2352x1568px. Color fundus image.
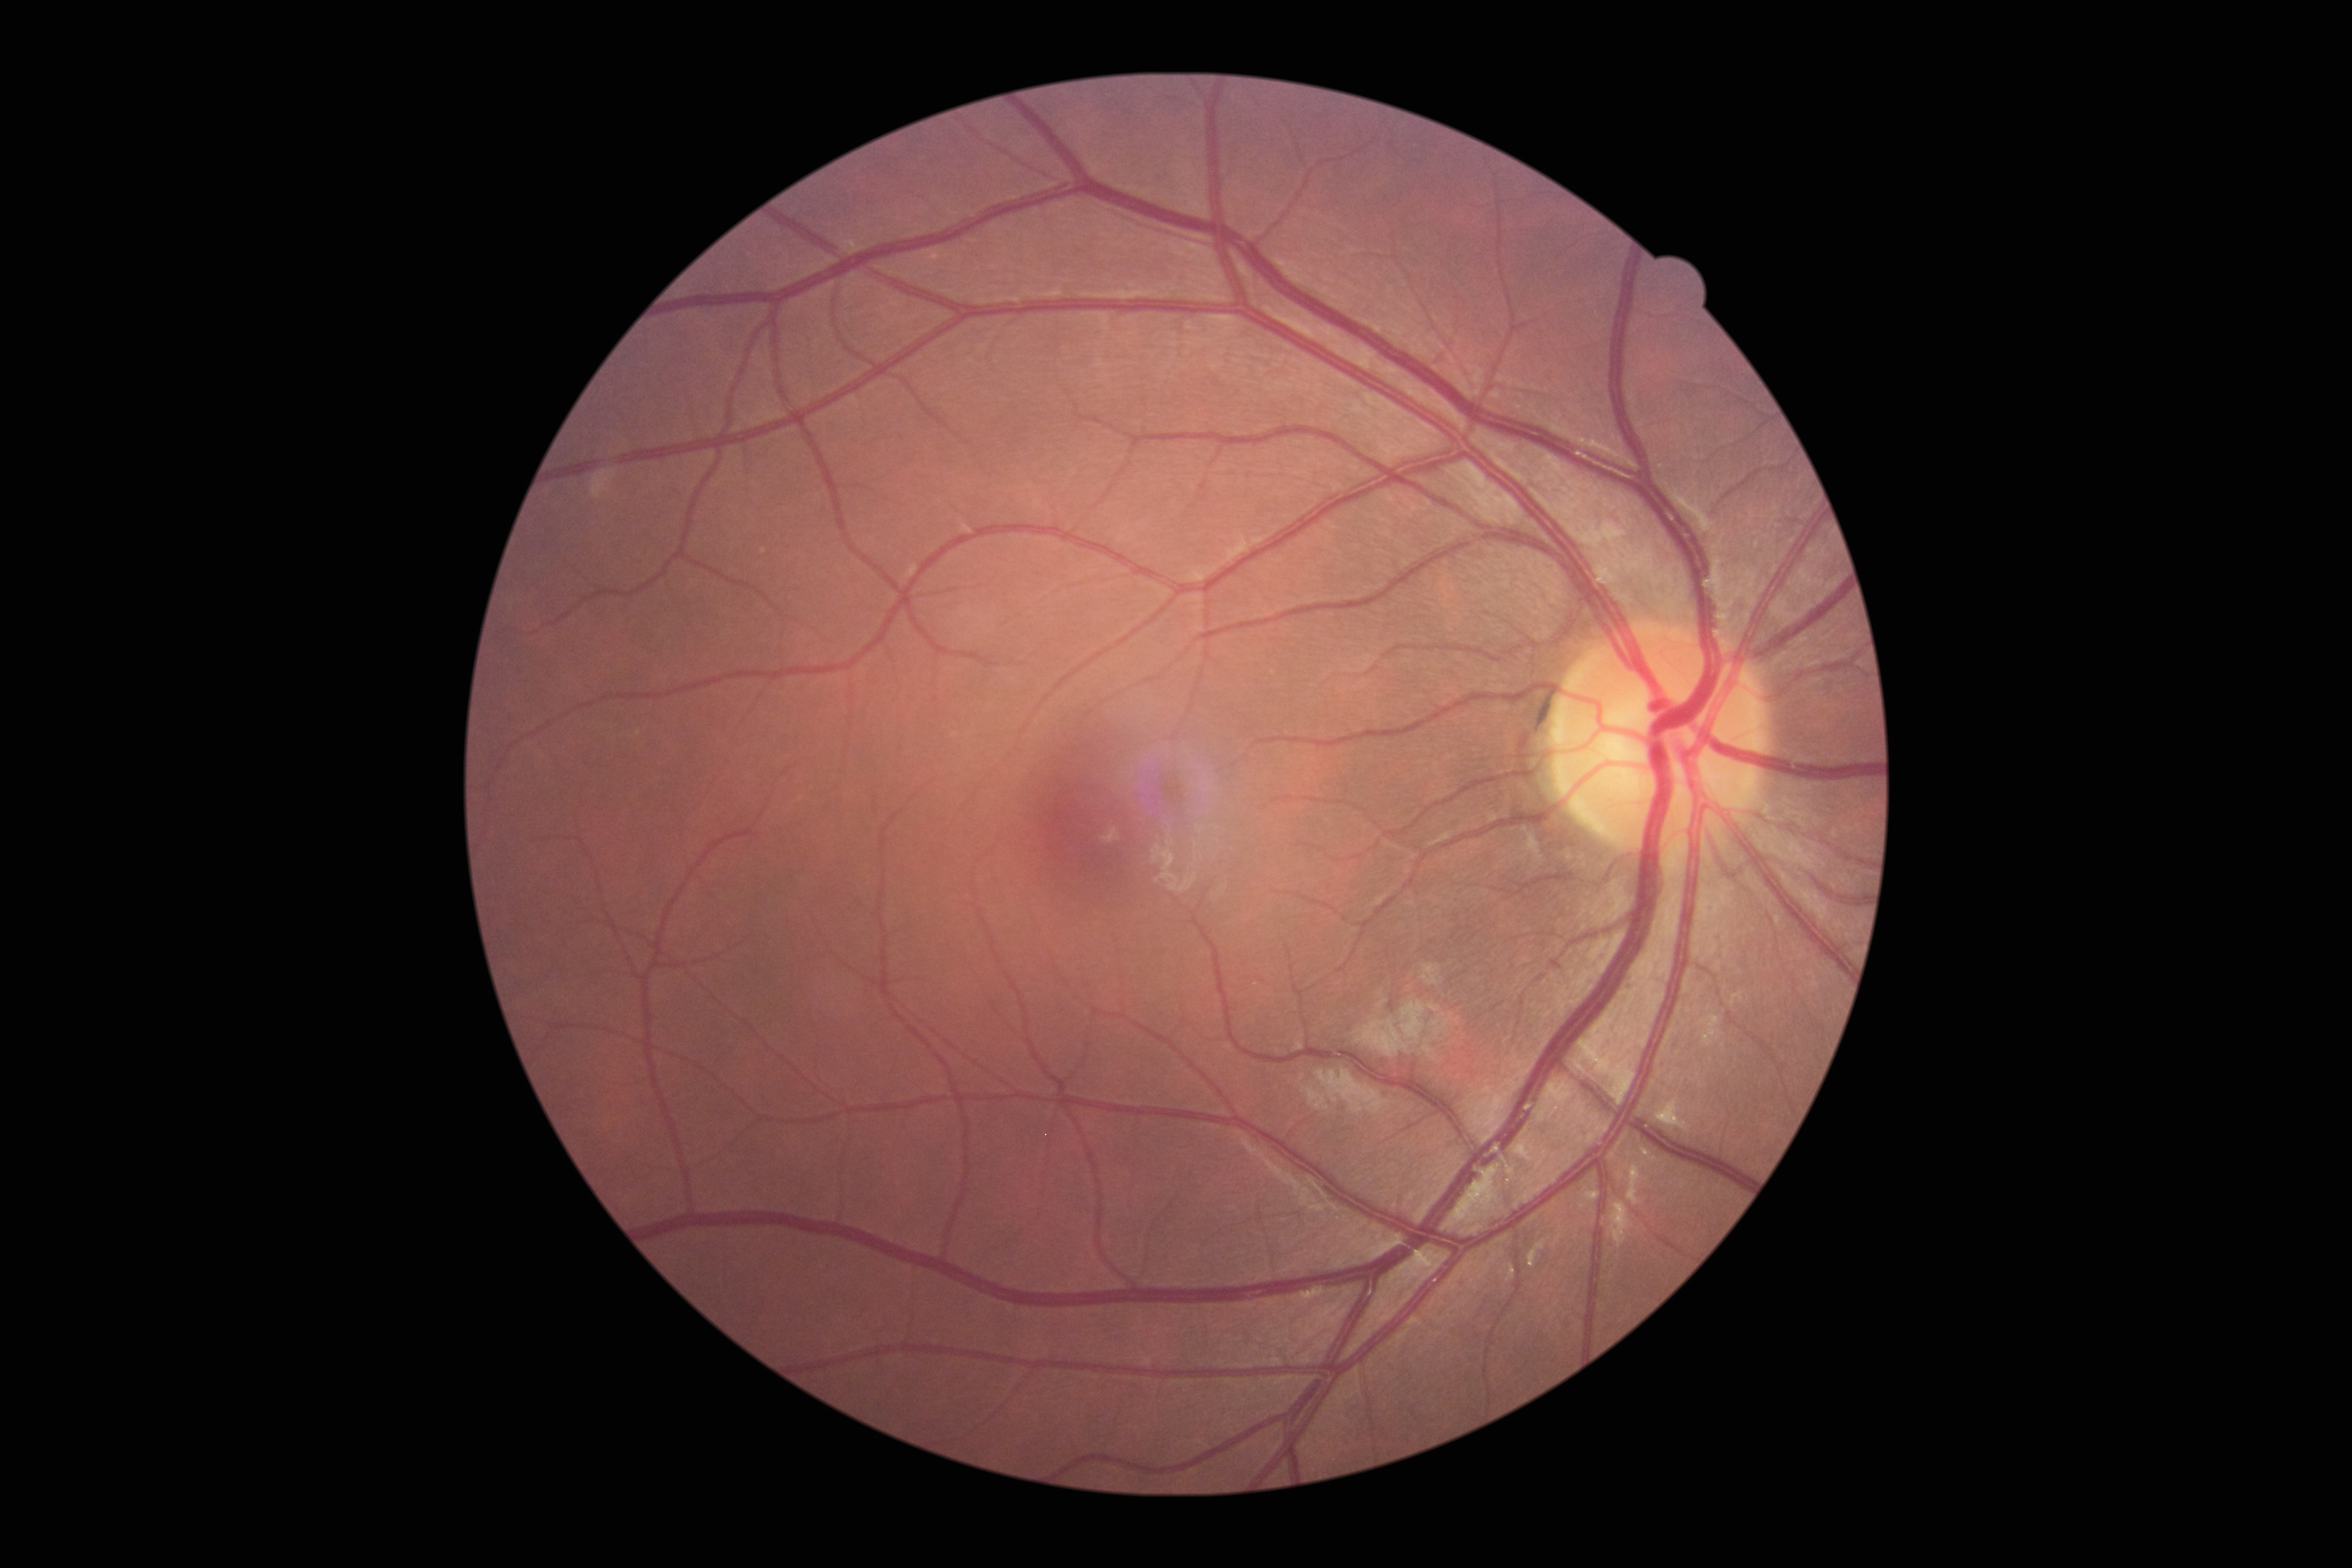
  dr_impression: no DR findings
  dr_grade: 0